848x848; no pharmacologic dilation; posterior pole color fundus photograph: 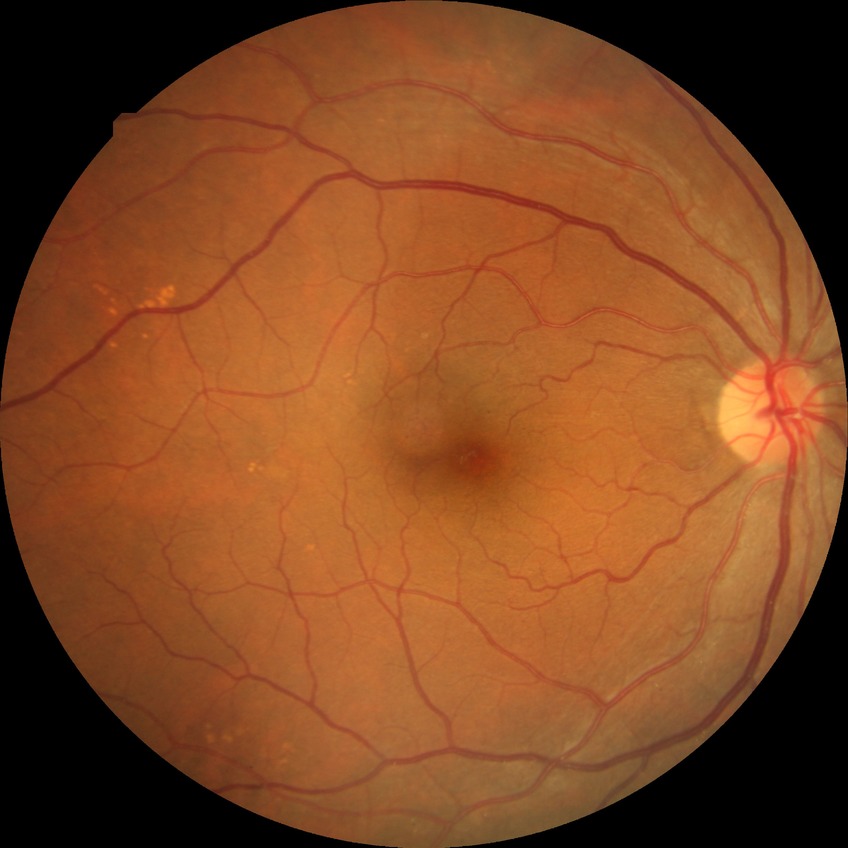

DR class: non-proliferative diabetic retinopathy.
Diabetic retinopathy grade: simple diabetic retinopathy.